CFP
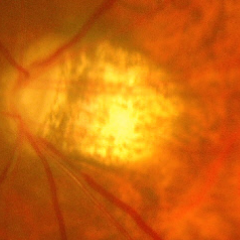
Advanced glaucoma.
Diagnostic criteria: near-total cupping of the optic nerve head, with or without severe visual field loss within the central 10 degrees of fixation.